2102 by 1736 pixels: 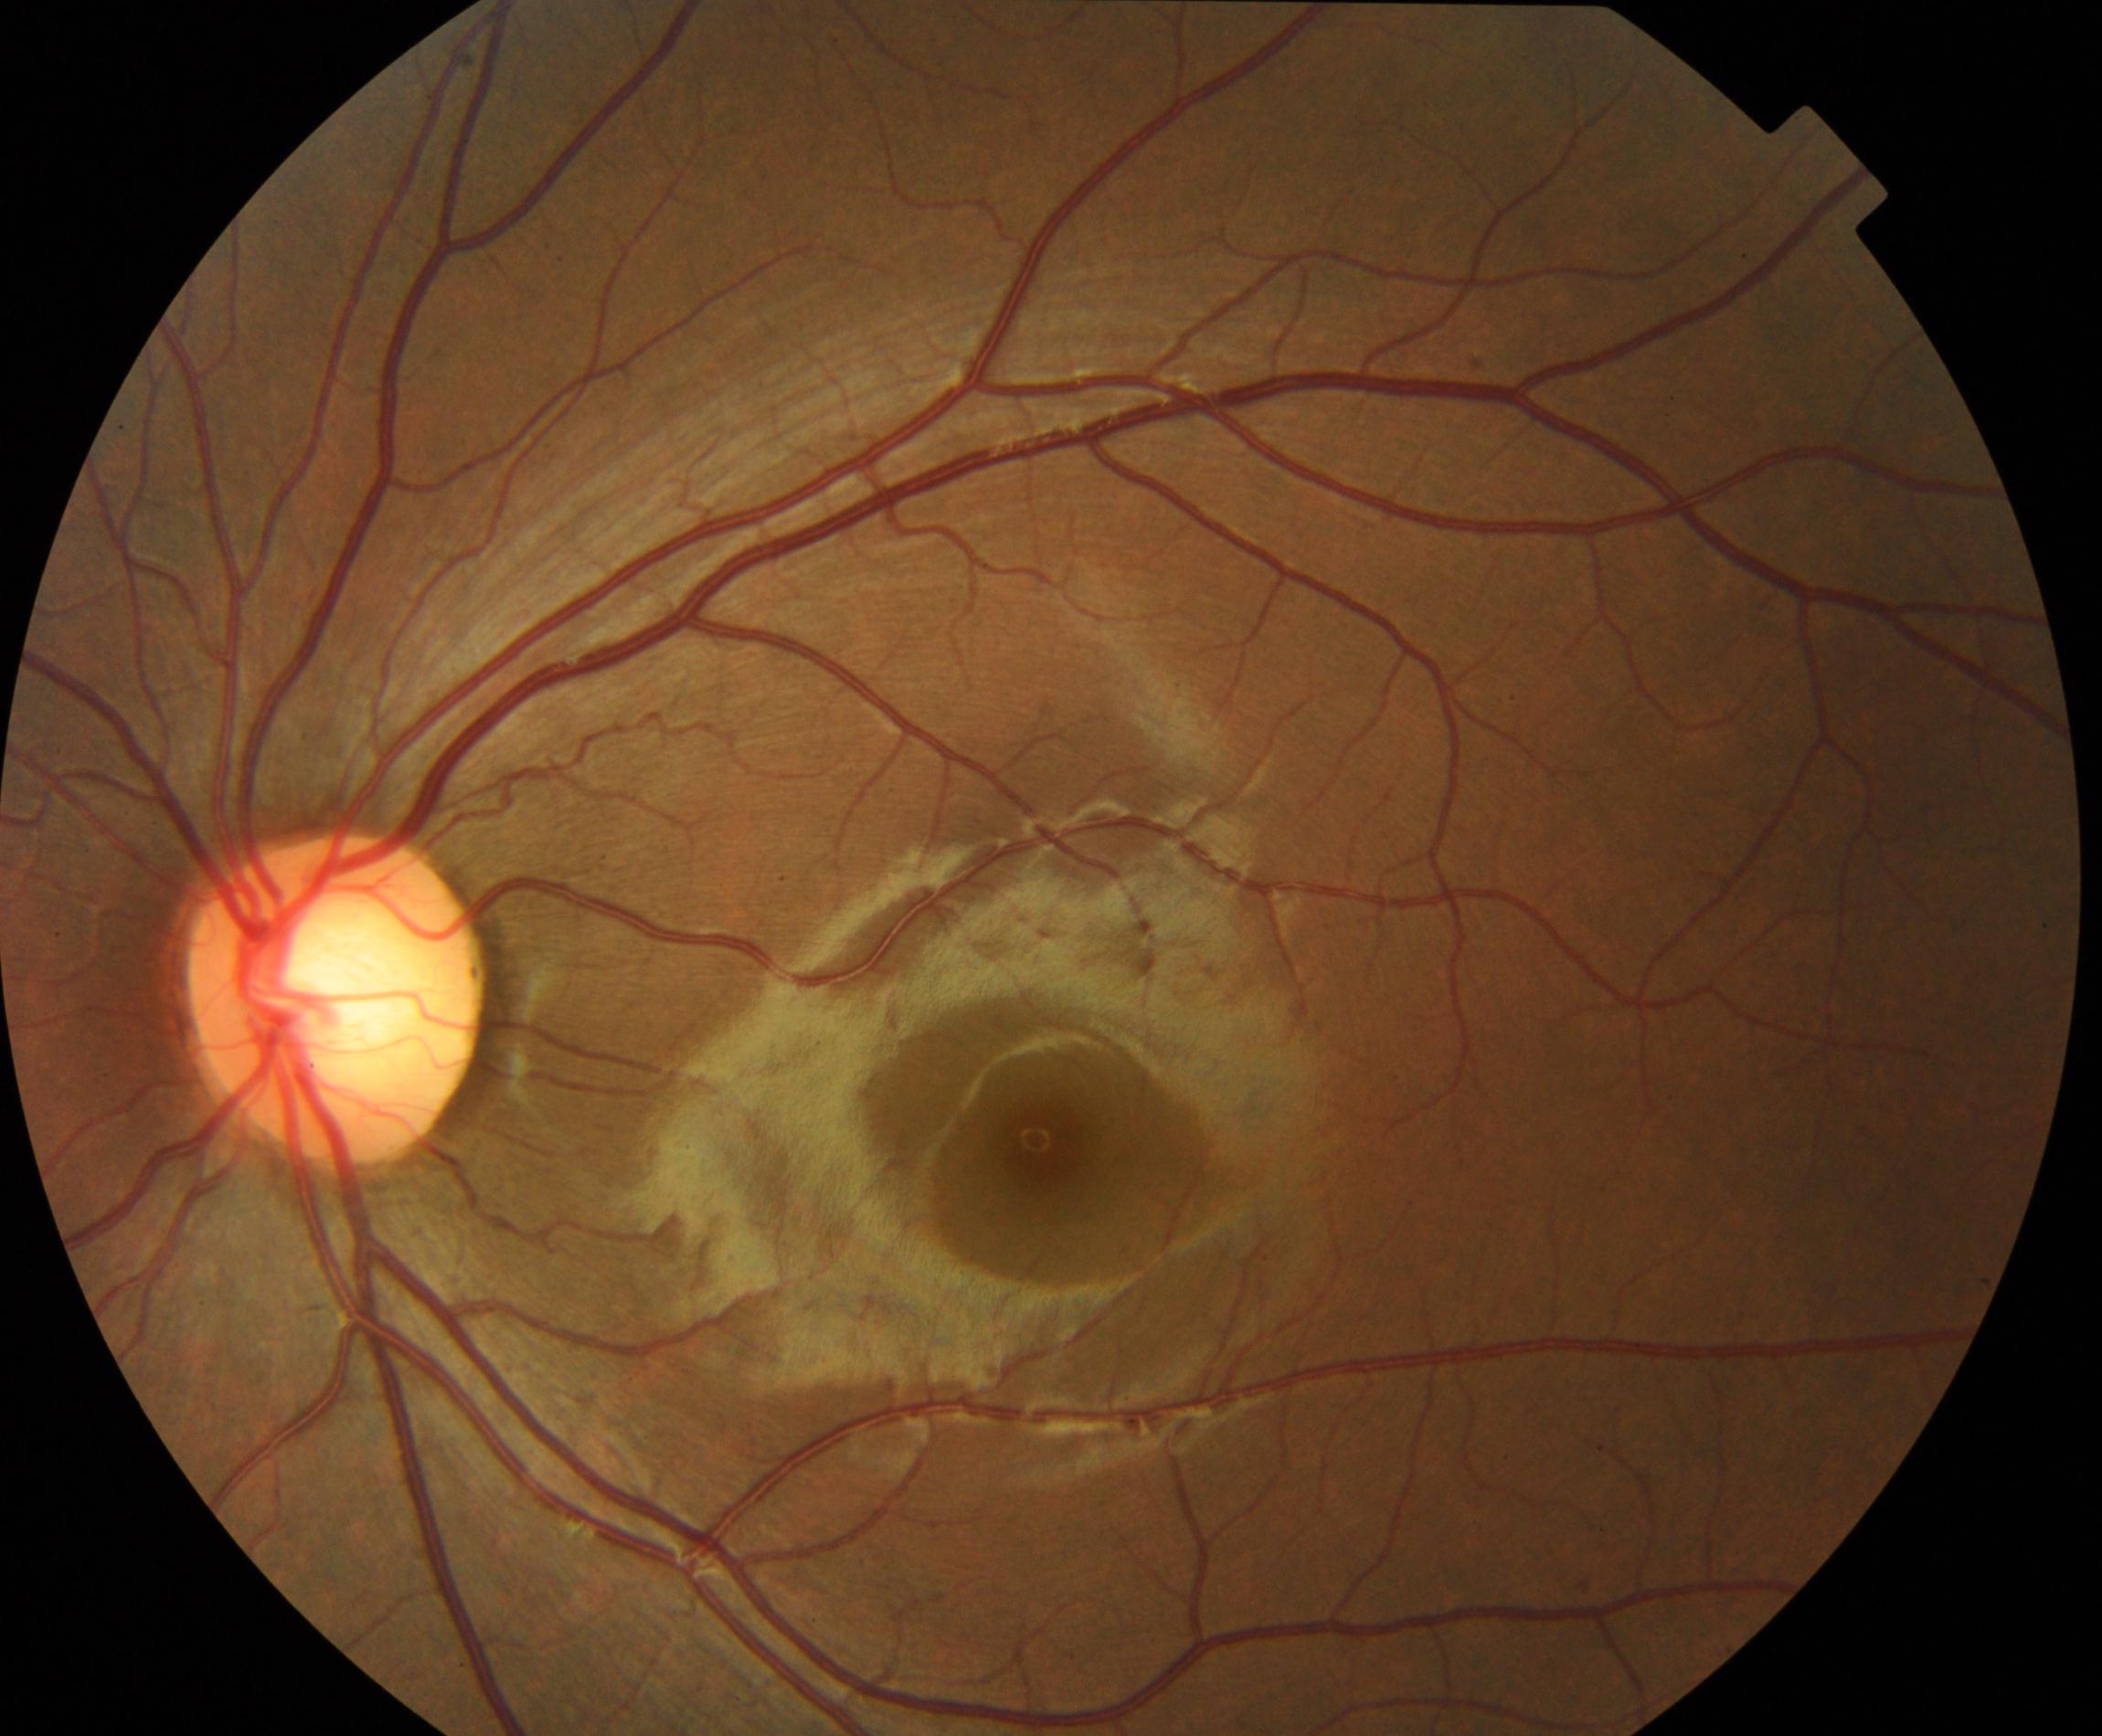 Appearance consistent with large optic cup.